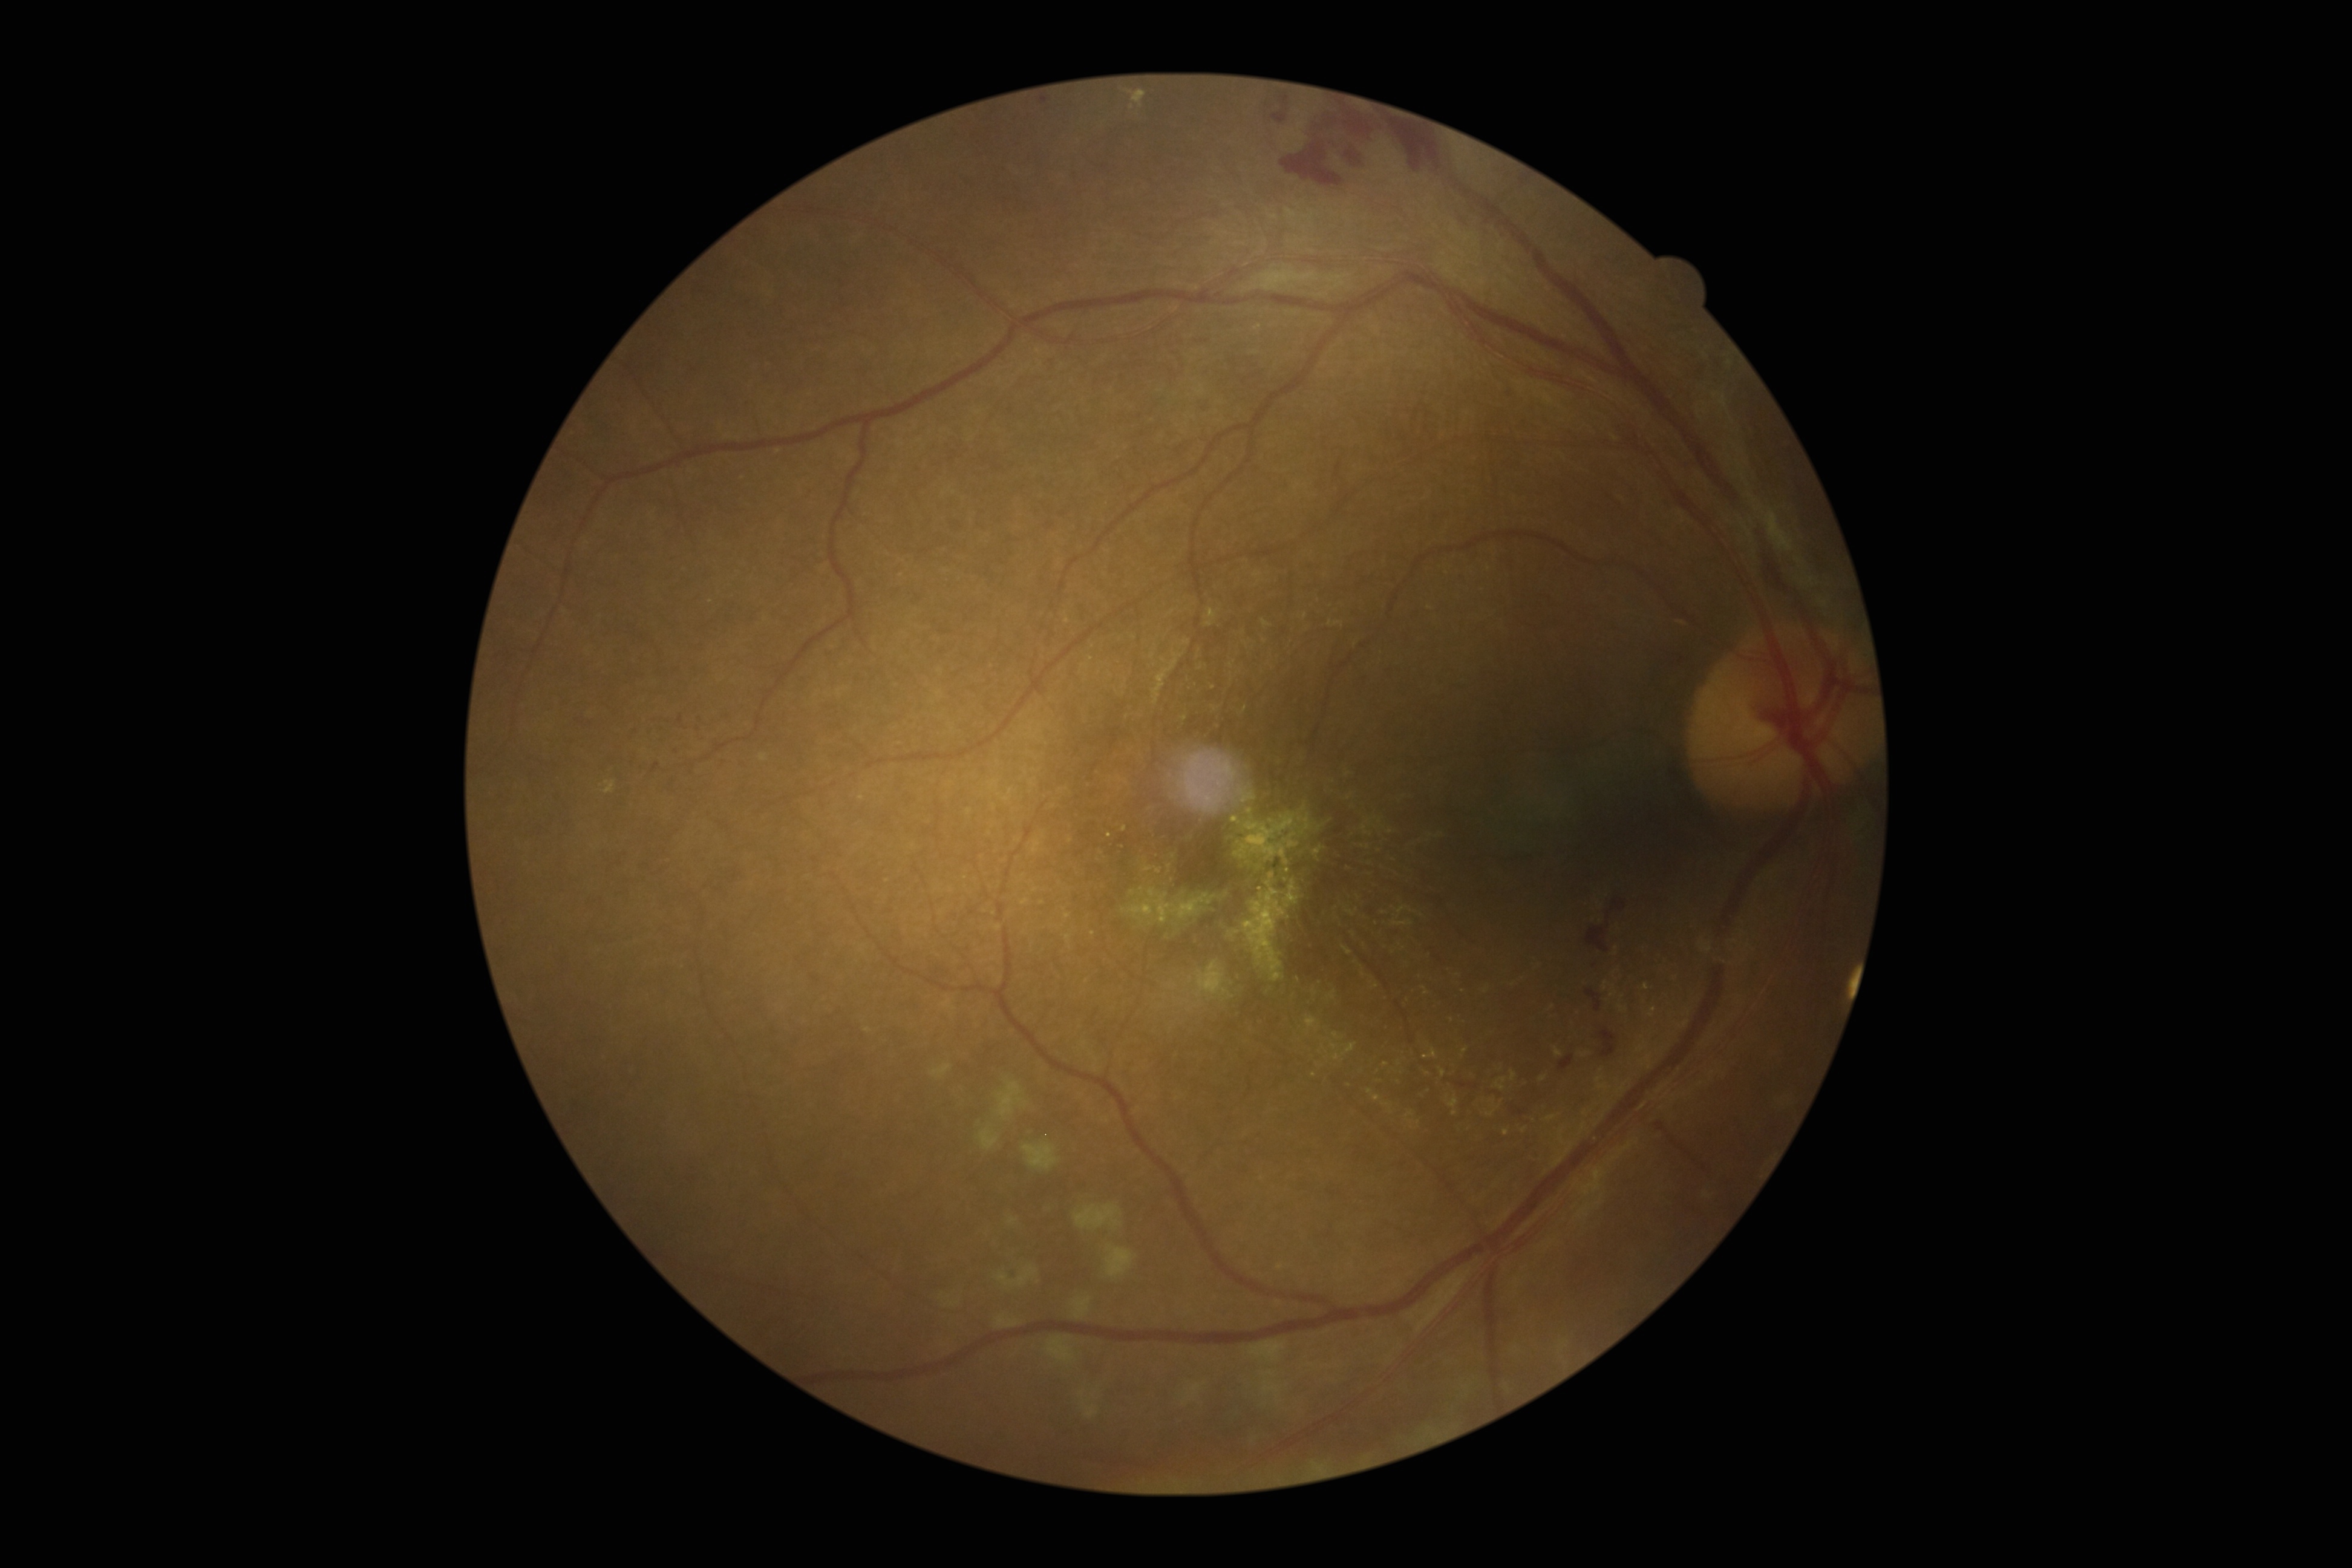

Diabetic retinopathy (DR) is grade 4 (PDR).